2184 by 1690 pixels. 45° field of view. Retinal fundus photograph.
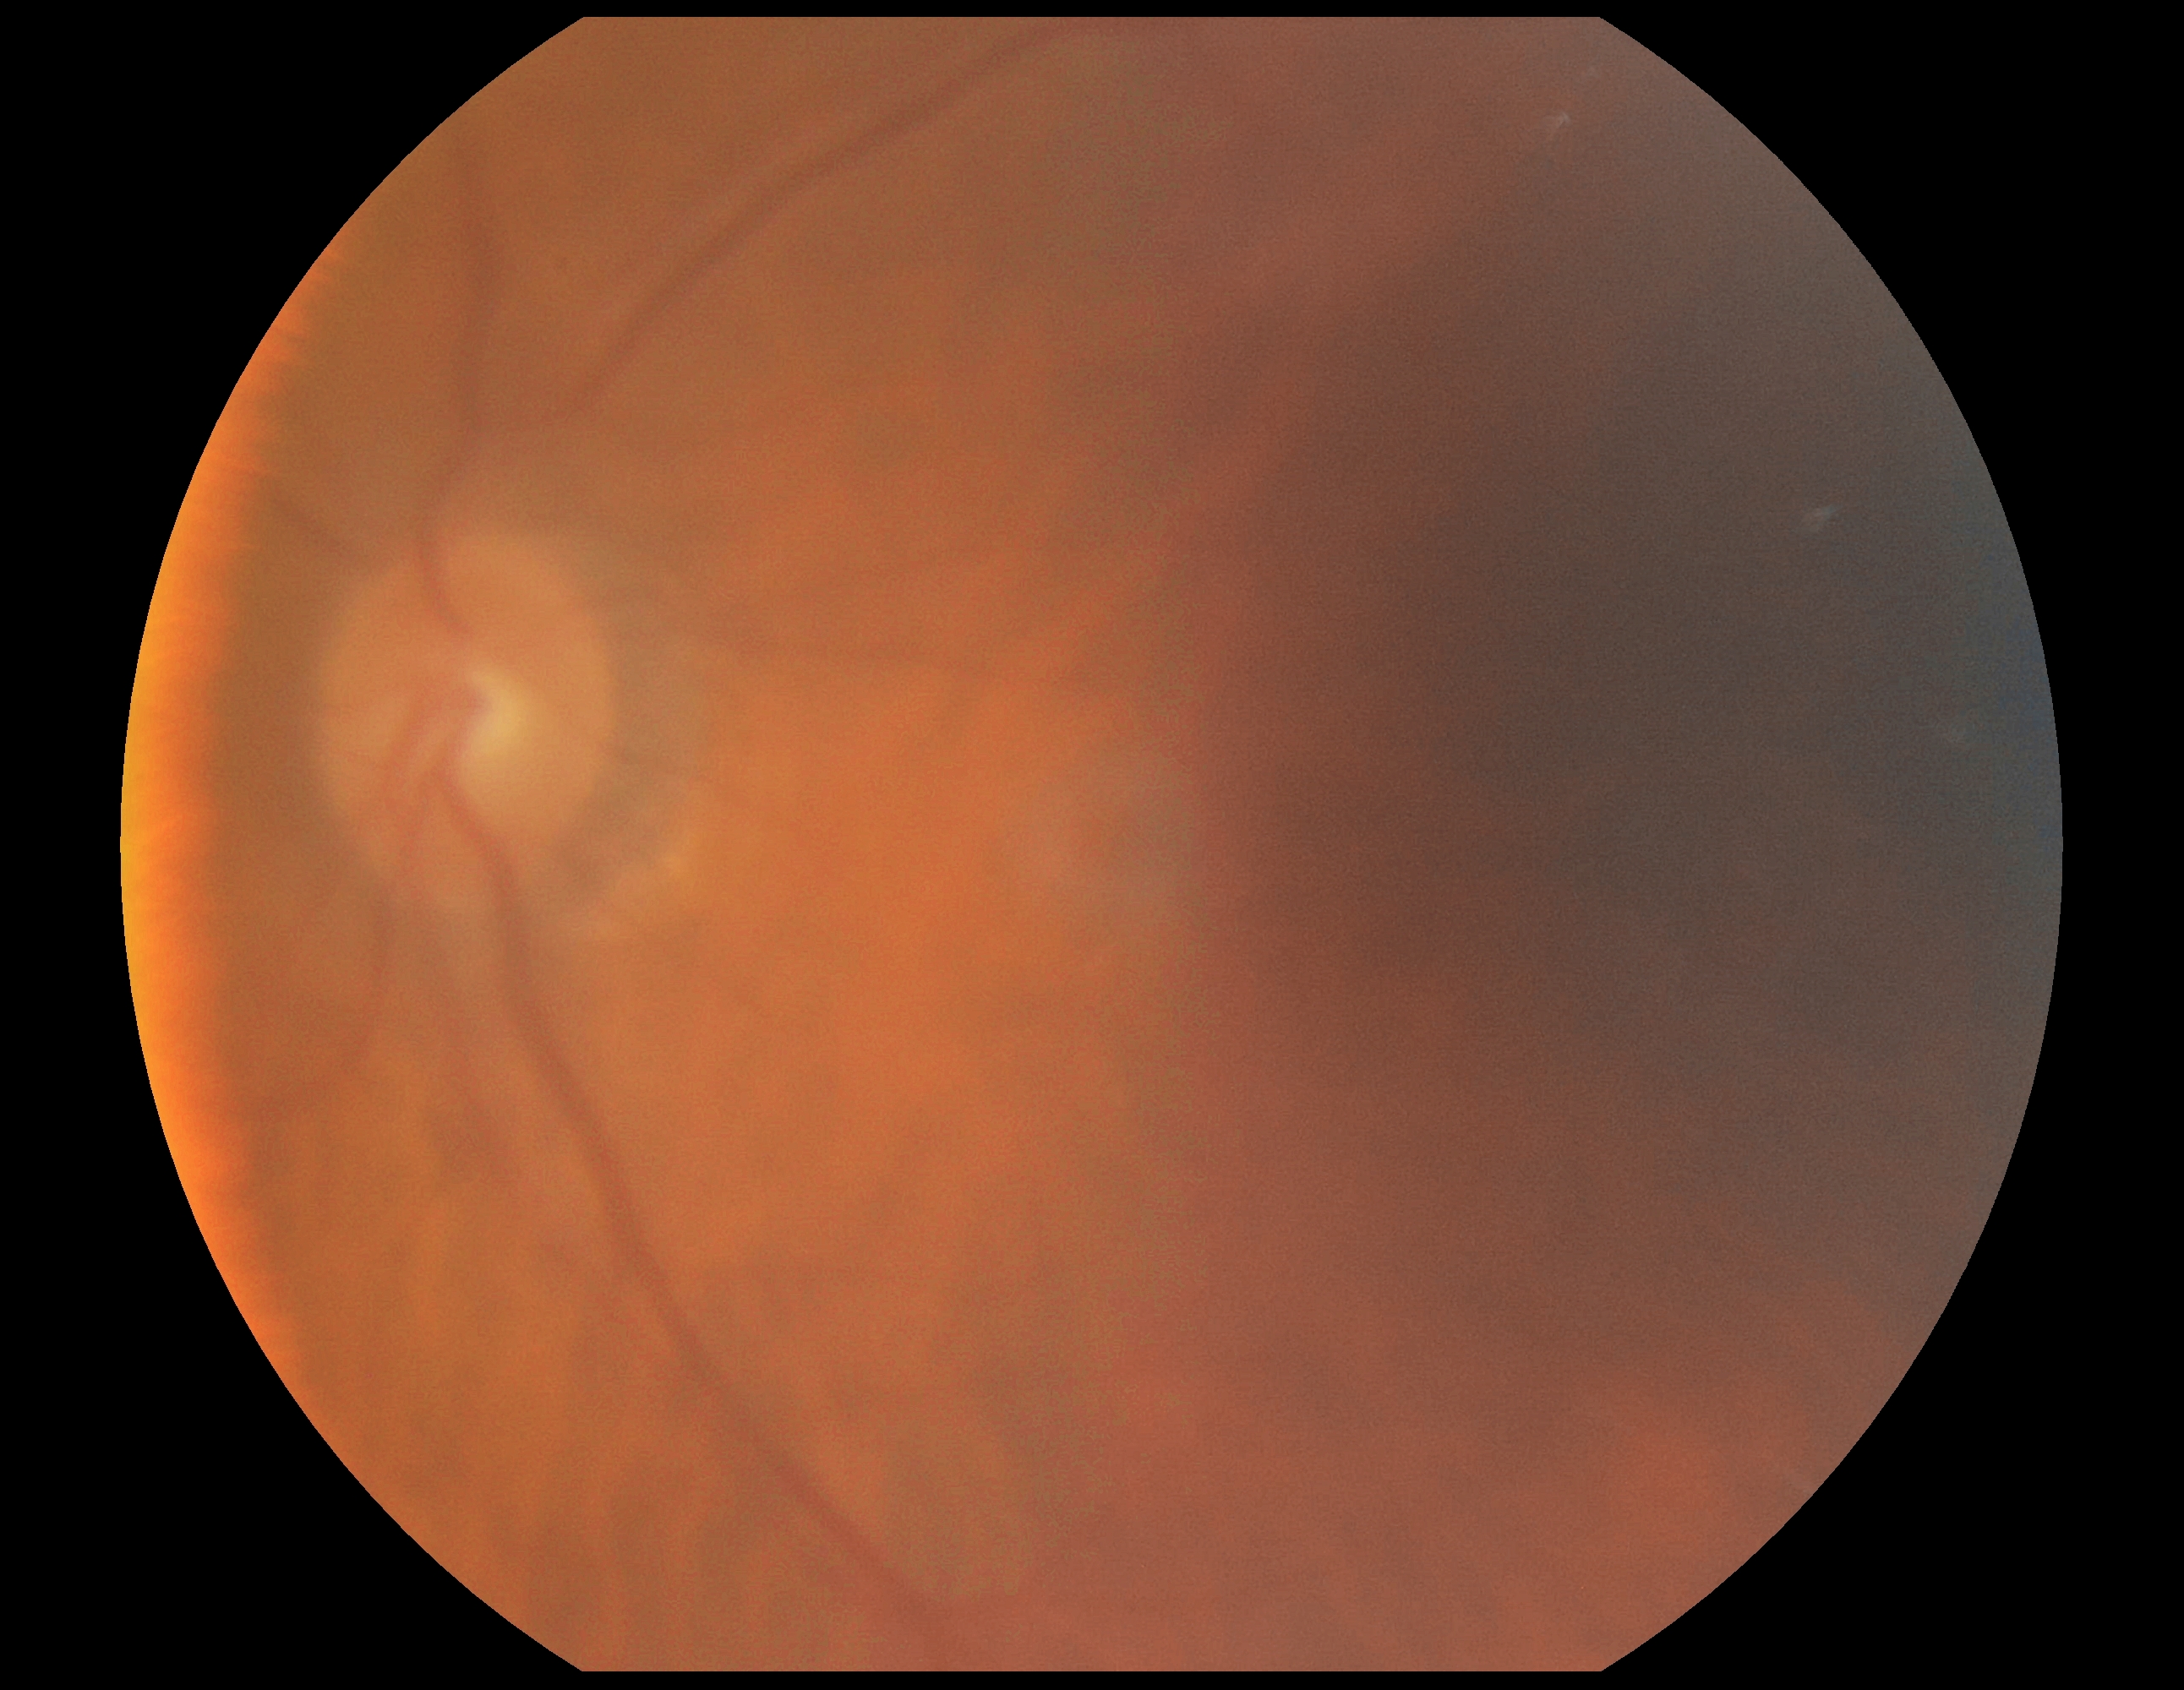

No DR findings.
Diabetic retinopathy (DR) is 0/4.